DR severity per modified Davis staging — 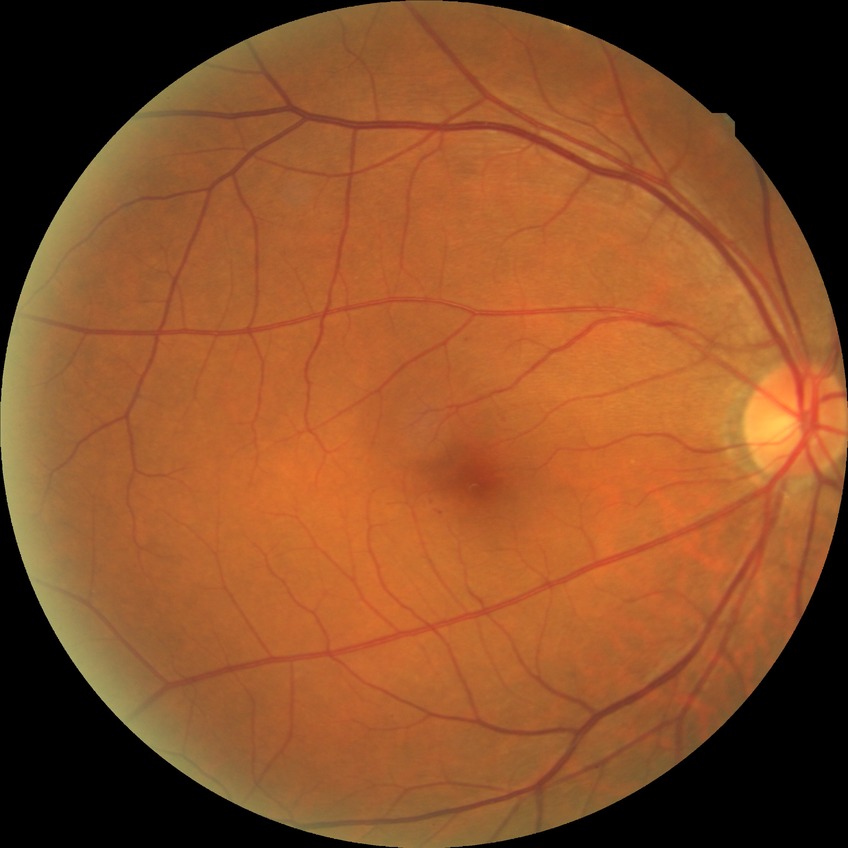
Annotations:
* DR class: non-proliferative diabetic retinopathy
* modified Davis grade: SDR